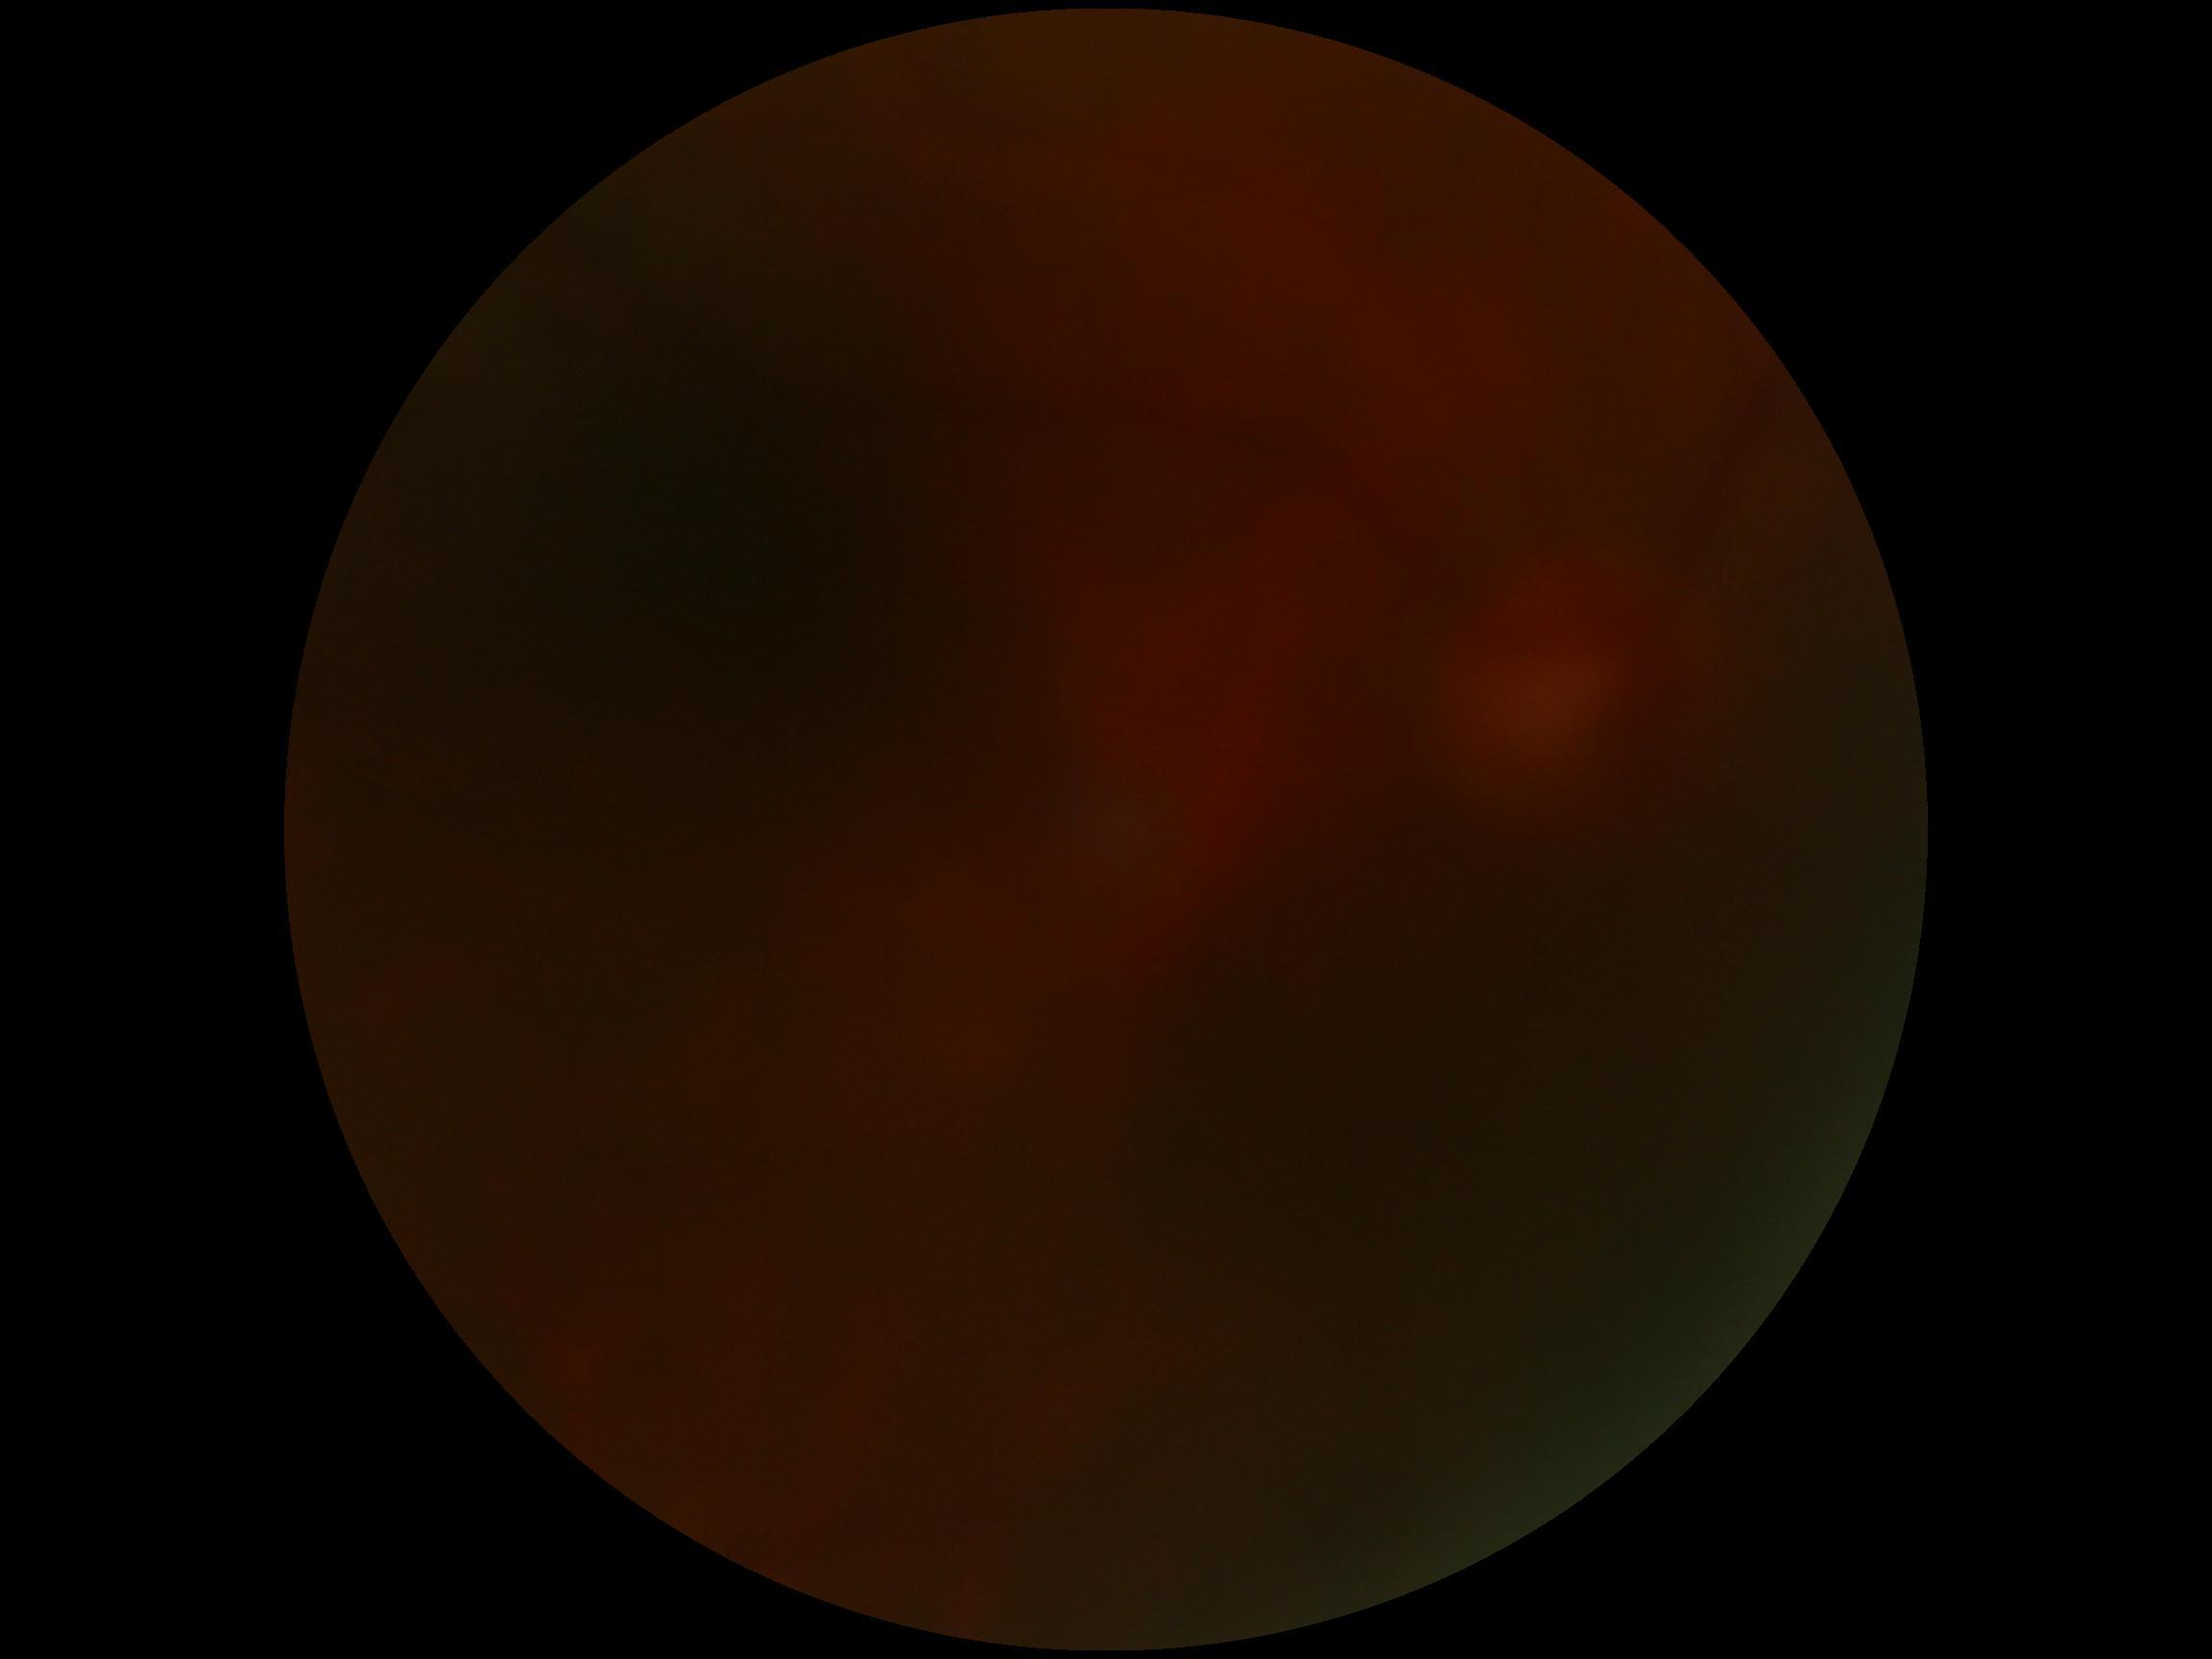 Quality too poor to assess for DR. DR stage: ungradable.